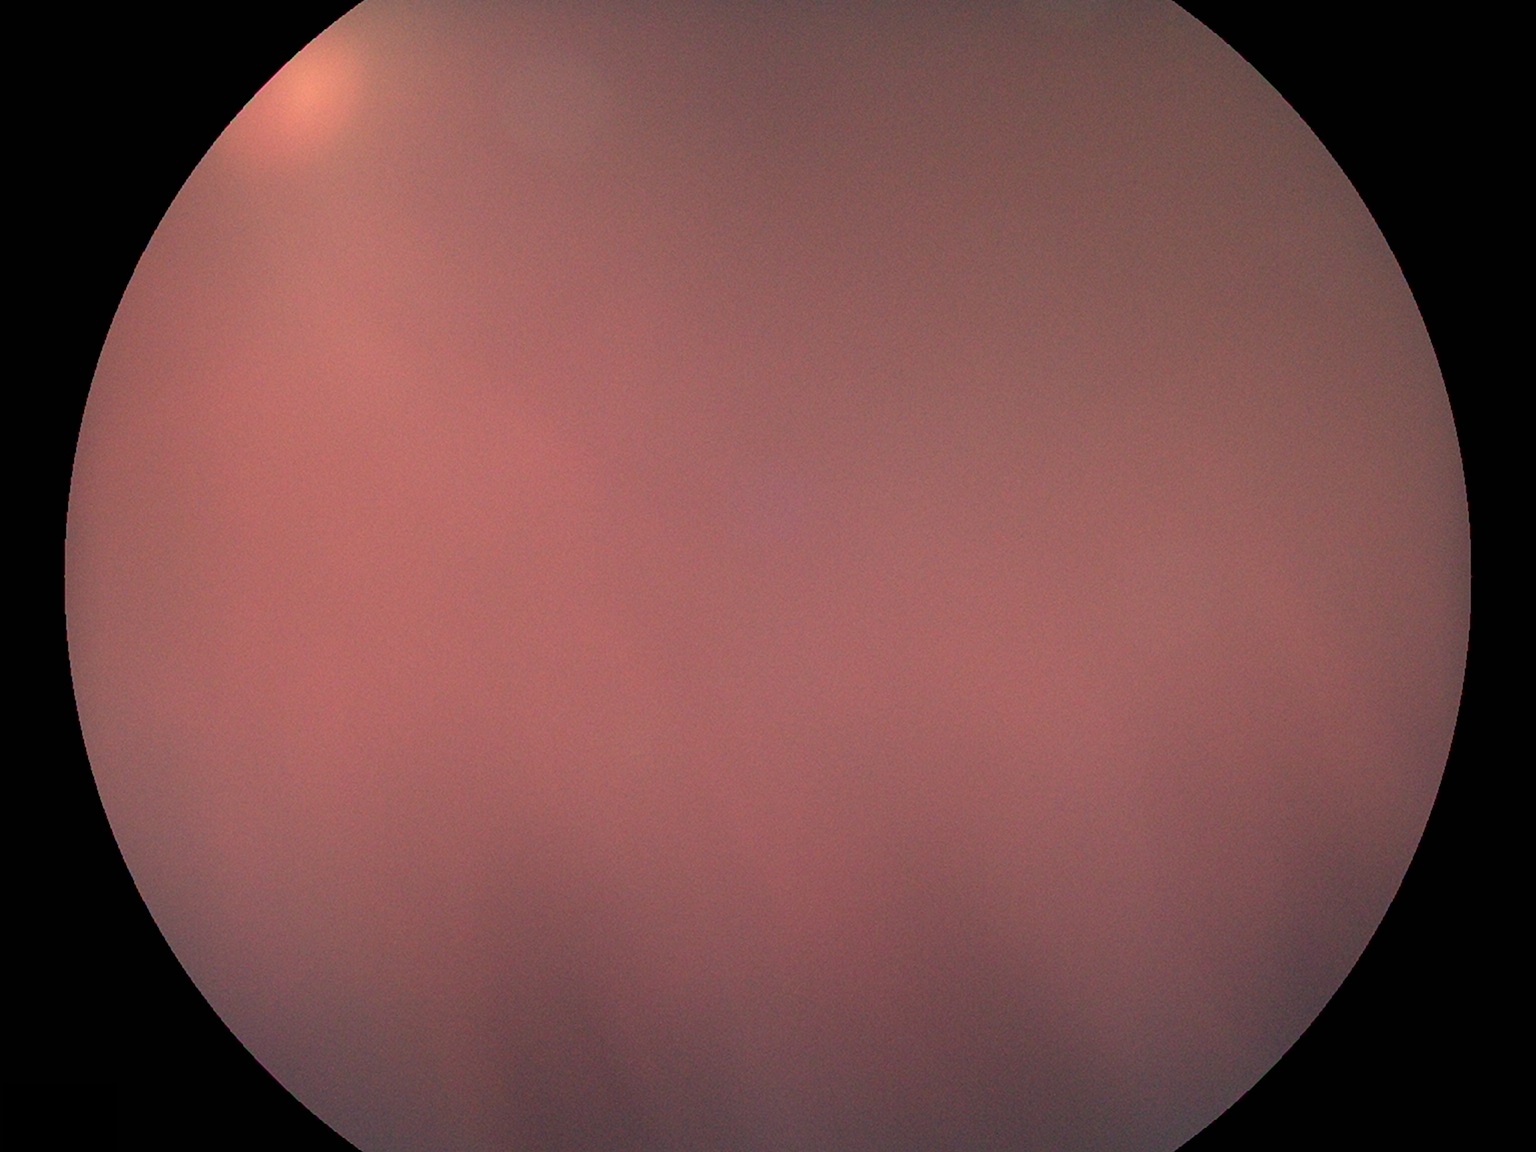

image quality=insufficient for DR assessment, DR=ungradable.